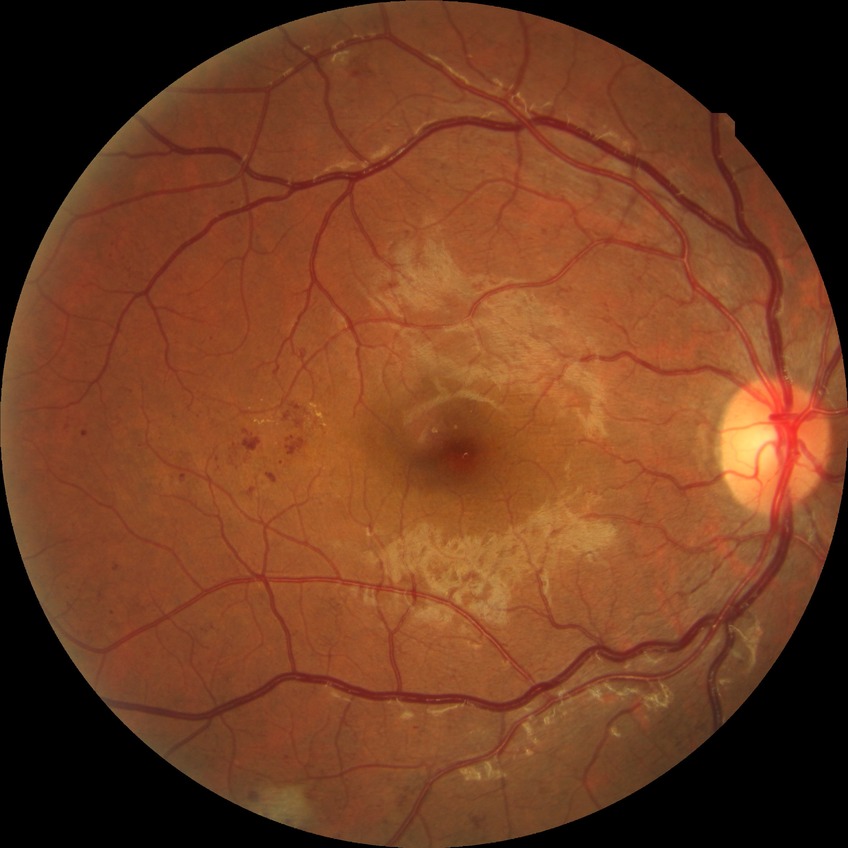
  davis_grade: PPDR
  proliferative_class: non-proliferative diabetic retinopathy